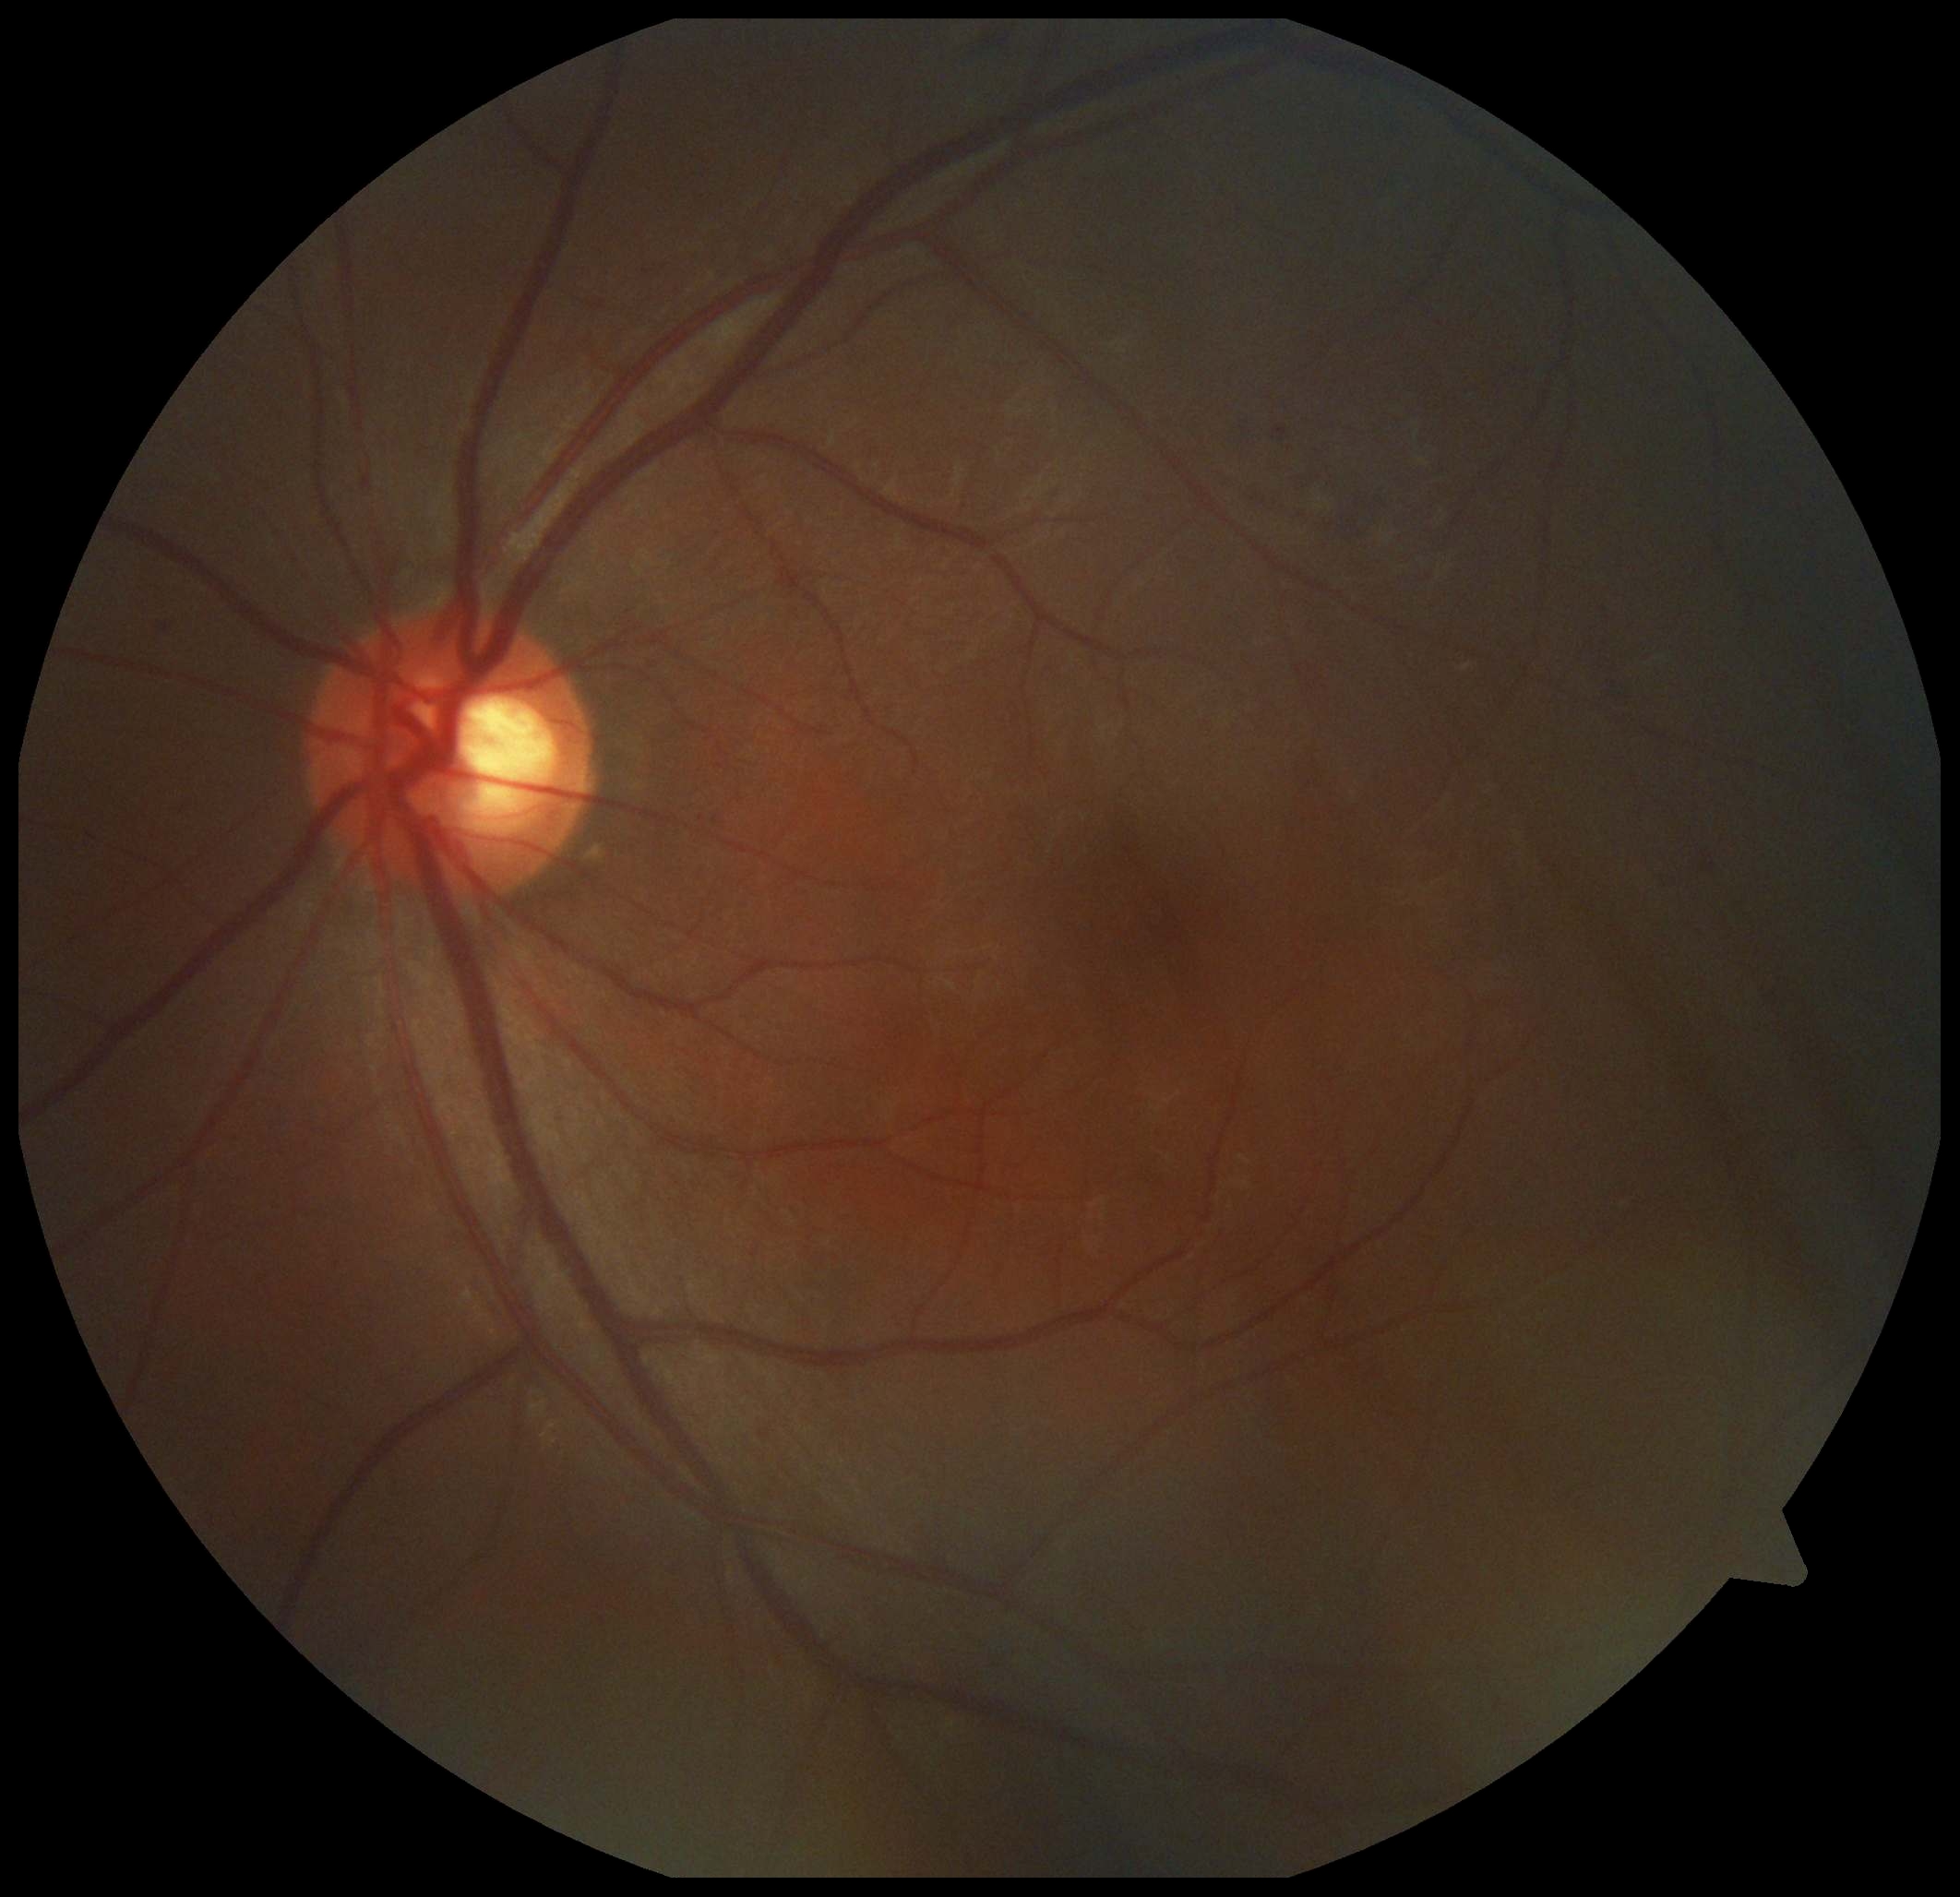
{
  "dr_grade": "2/4"
}